45-degree field of view.
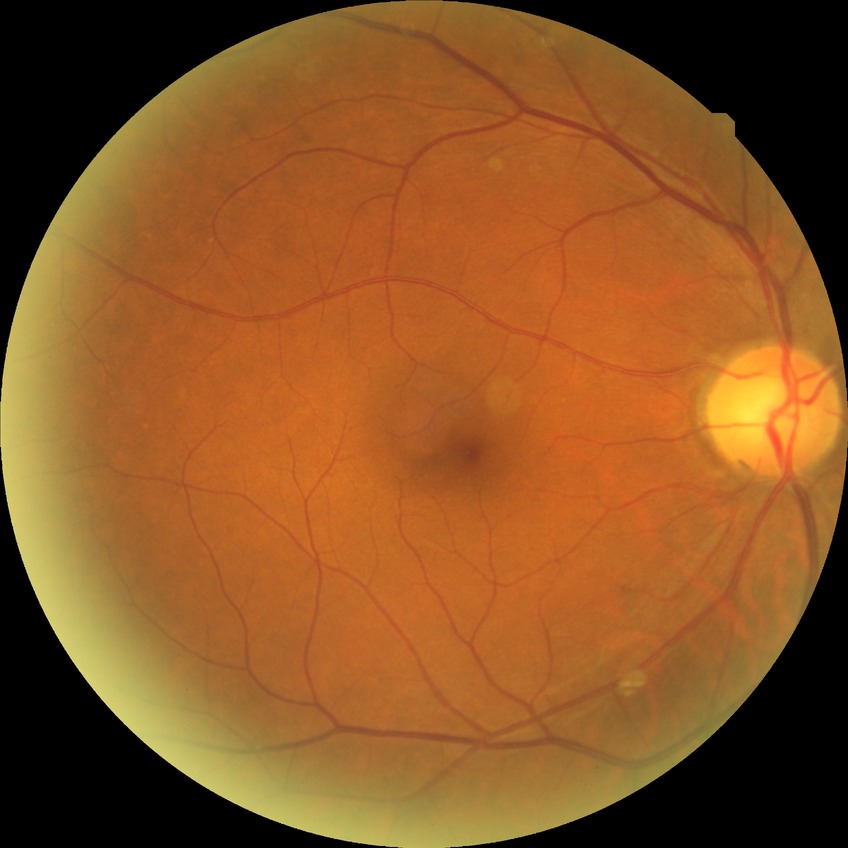

Diabetic retinopathy (DR) is NDR (no diabetic retinopathy).